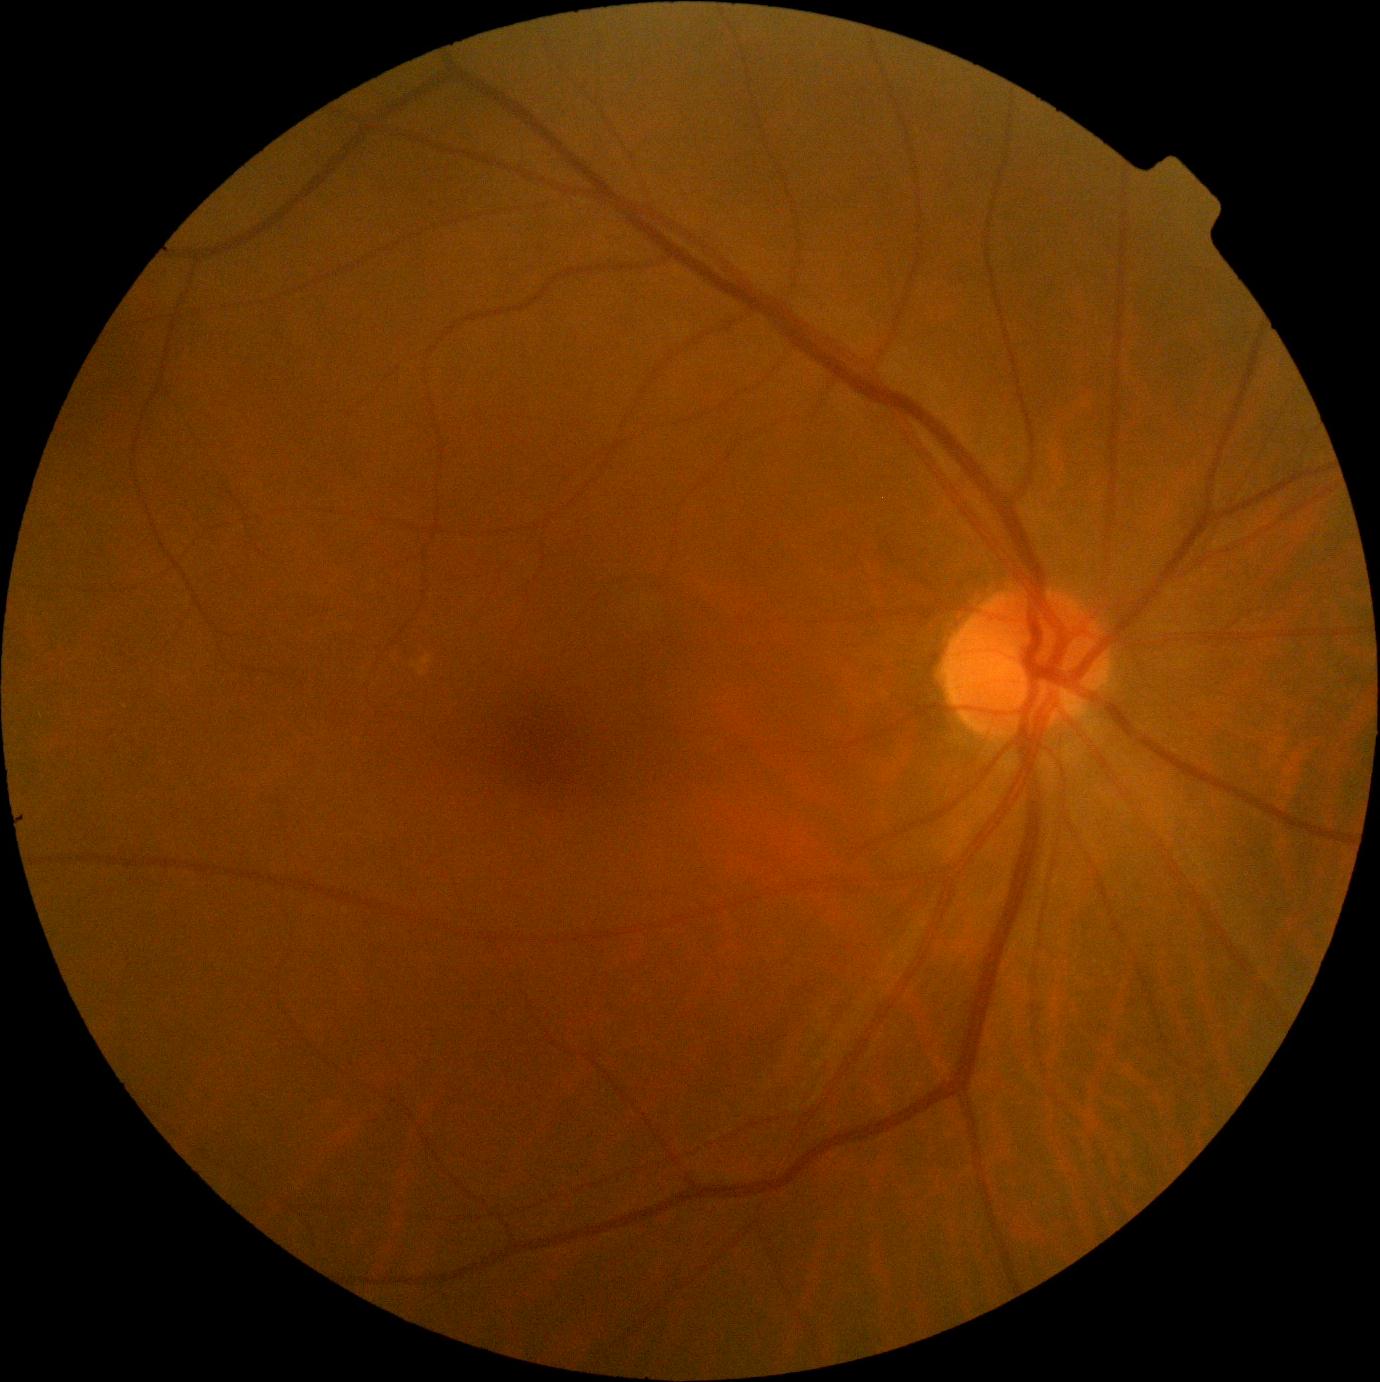 Retinopathy grade: 0 (no apparent retinopathy).